Color fundus image · Davis DR grading:
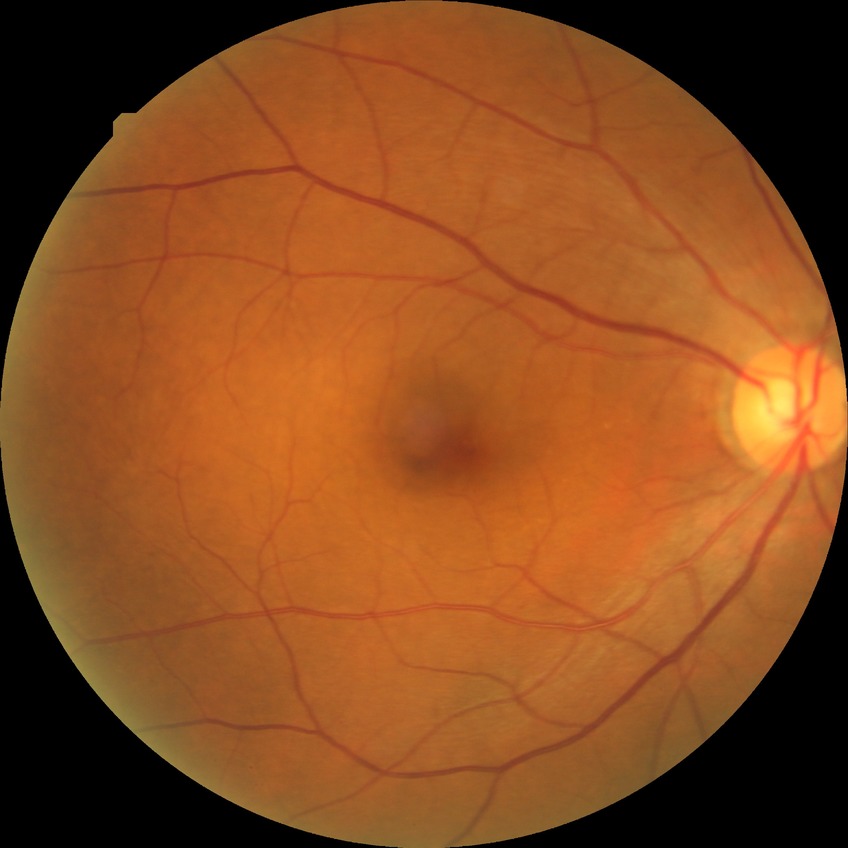 {"davis_grade": "no diabetic retinopathy (NDR)"}